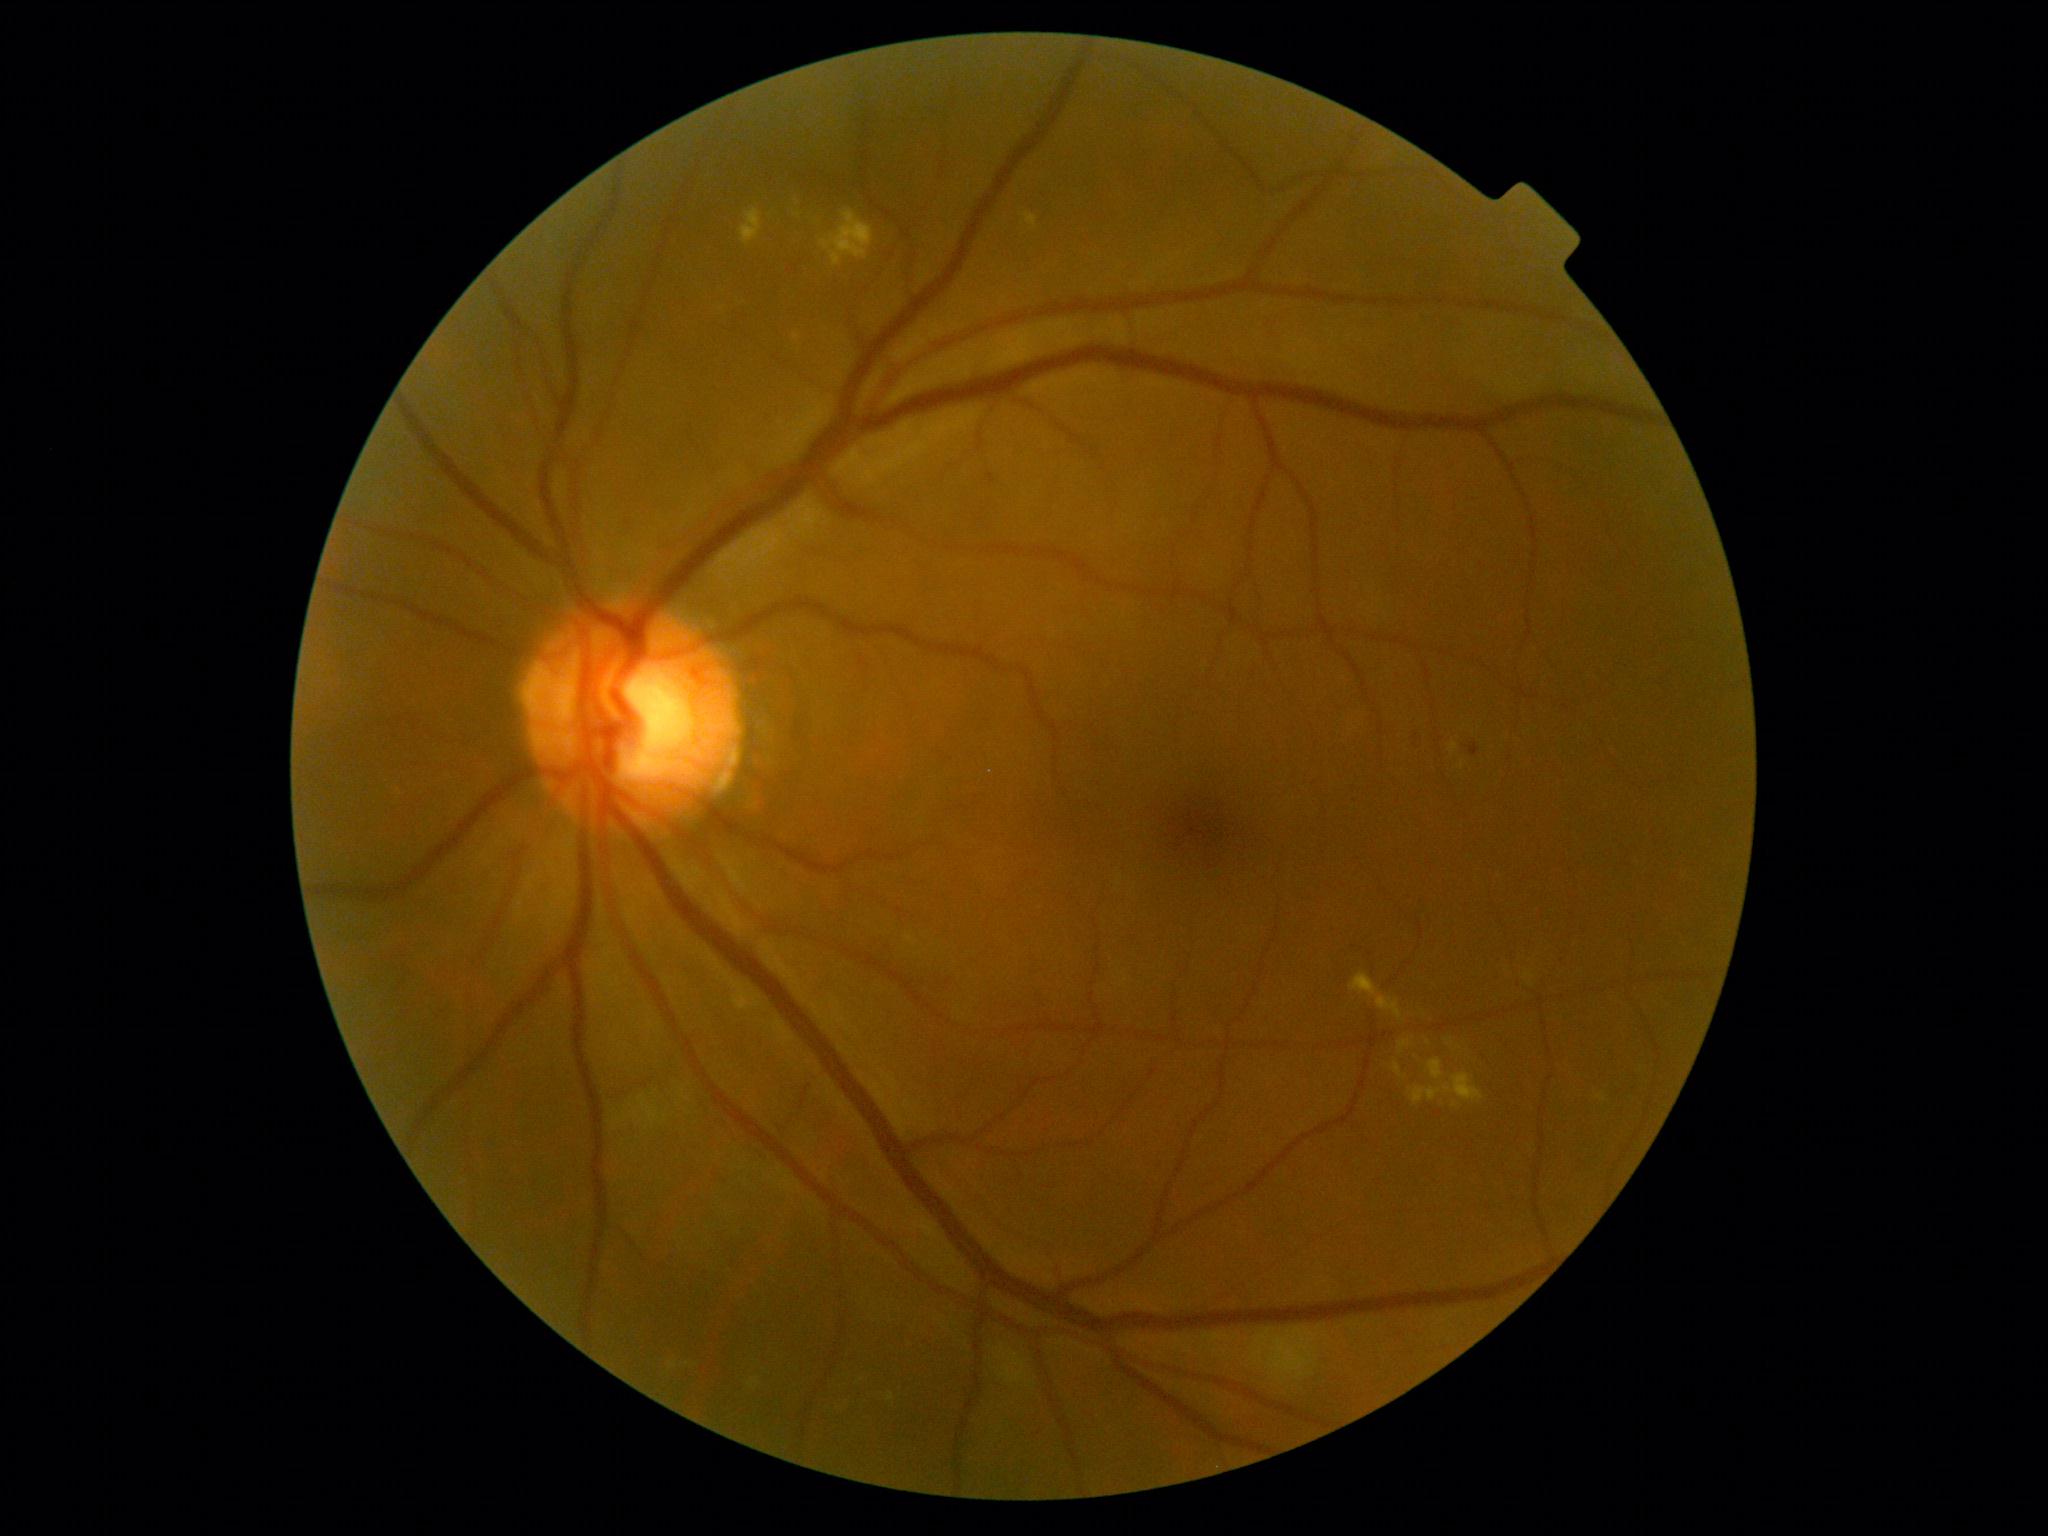
DR class = non-proliferative diabetic retinopathy, DR grade = 2/4.